2048 by 1536 pixels; fundus photo; 45° field of view
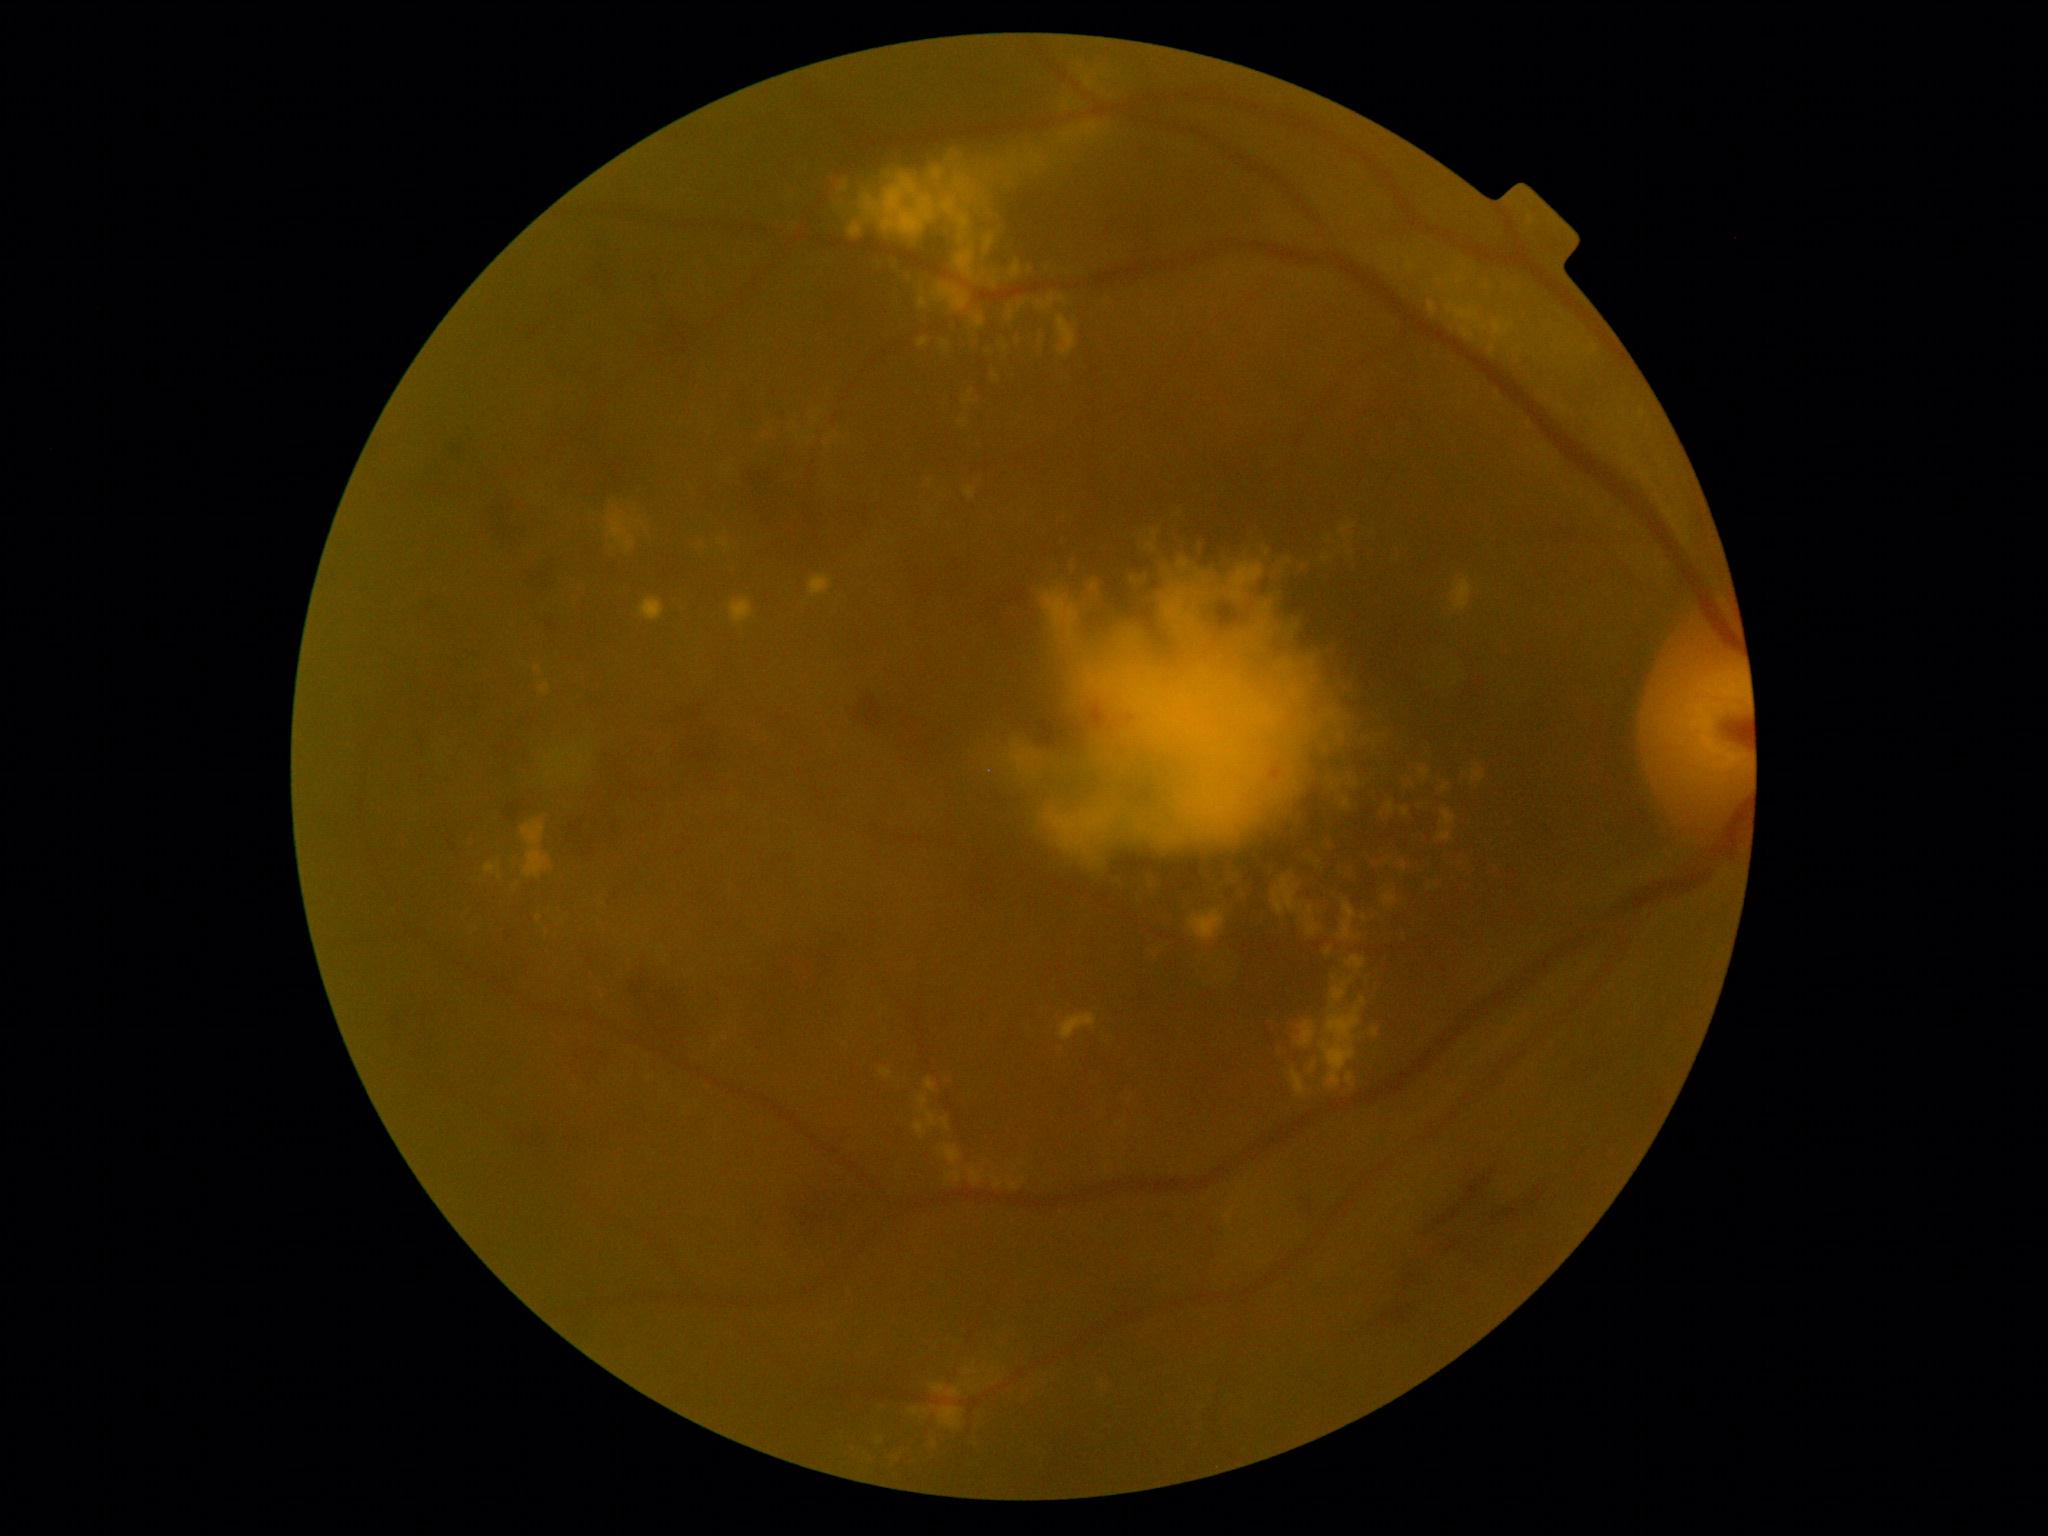

DR severity: grade 2 (moderate NPDR) — more than just microaneurysms but less than severe NPDR
A subset of detected lesions:
EXs (continued): 1325,948,1332,956; 1007,310,1014,320; 1281,1051,1301,1068; 980,744,1010,771; 1036,329,1047,357; 1350,684,1360,697; 1067,57,1107,90; 532,661,549,674; 1321,998,1367,1090; 1272,895,1304,916; 1180,896,1192,912; 1407,262,1416,274; 1384,893,1397,906; 836,201,863,238; 730,601,754,624; 1146,939,1166,959
Small EXs near <pt>1439,281</pt>; <pt>1388,863</pt>